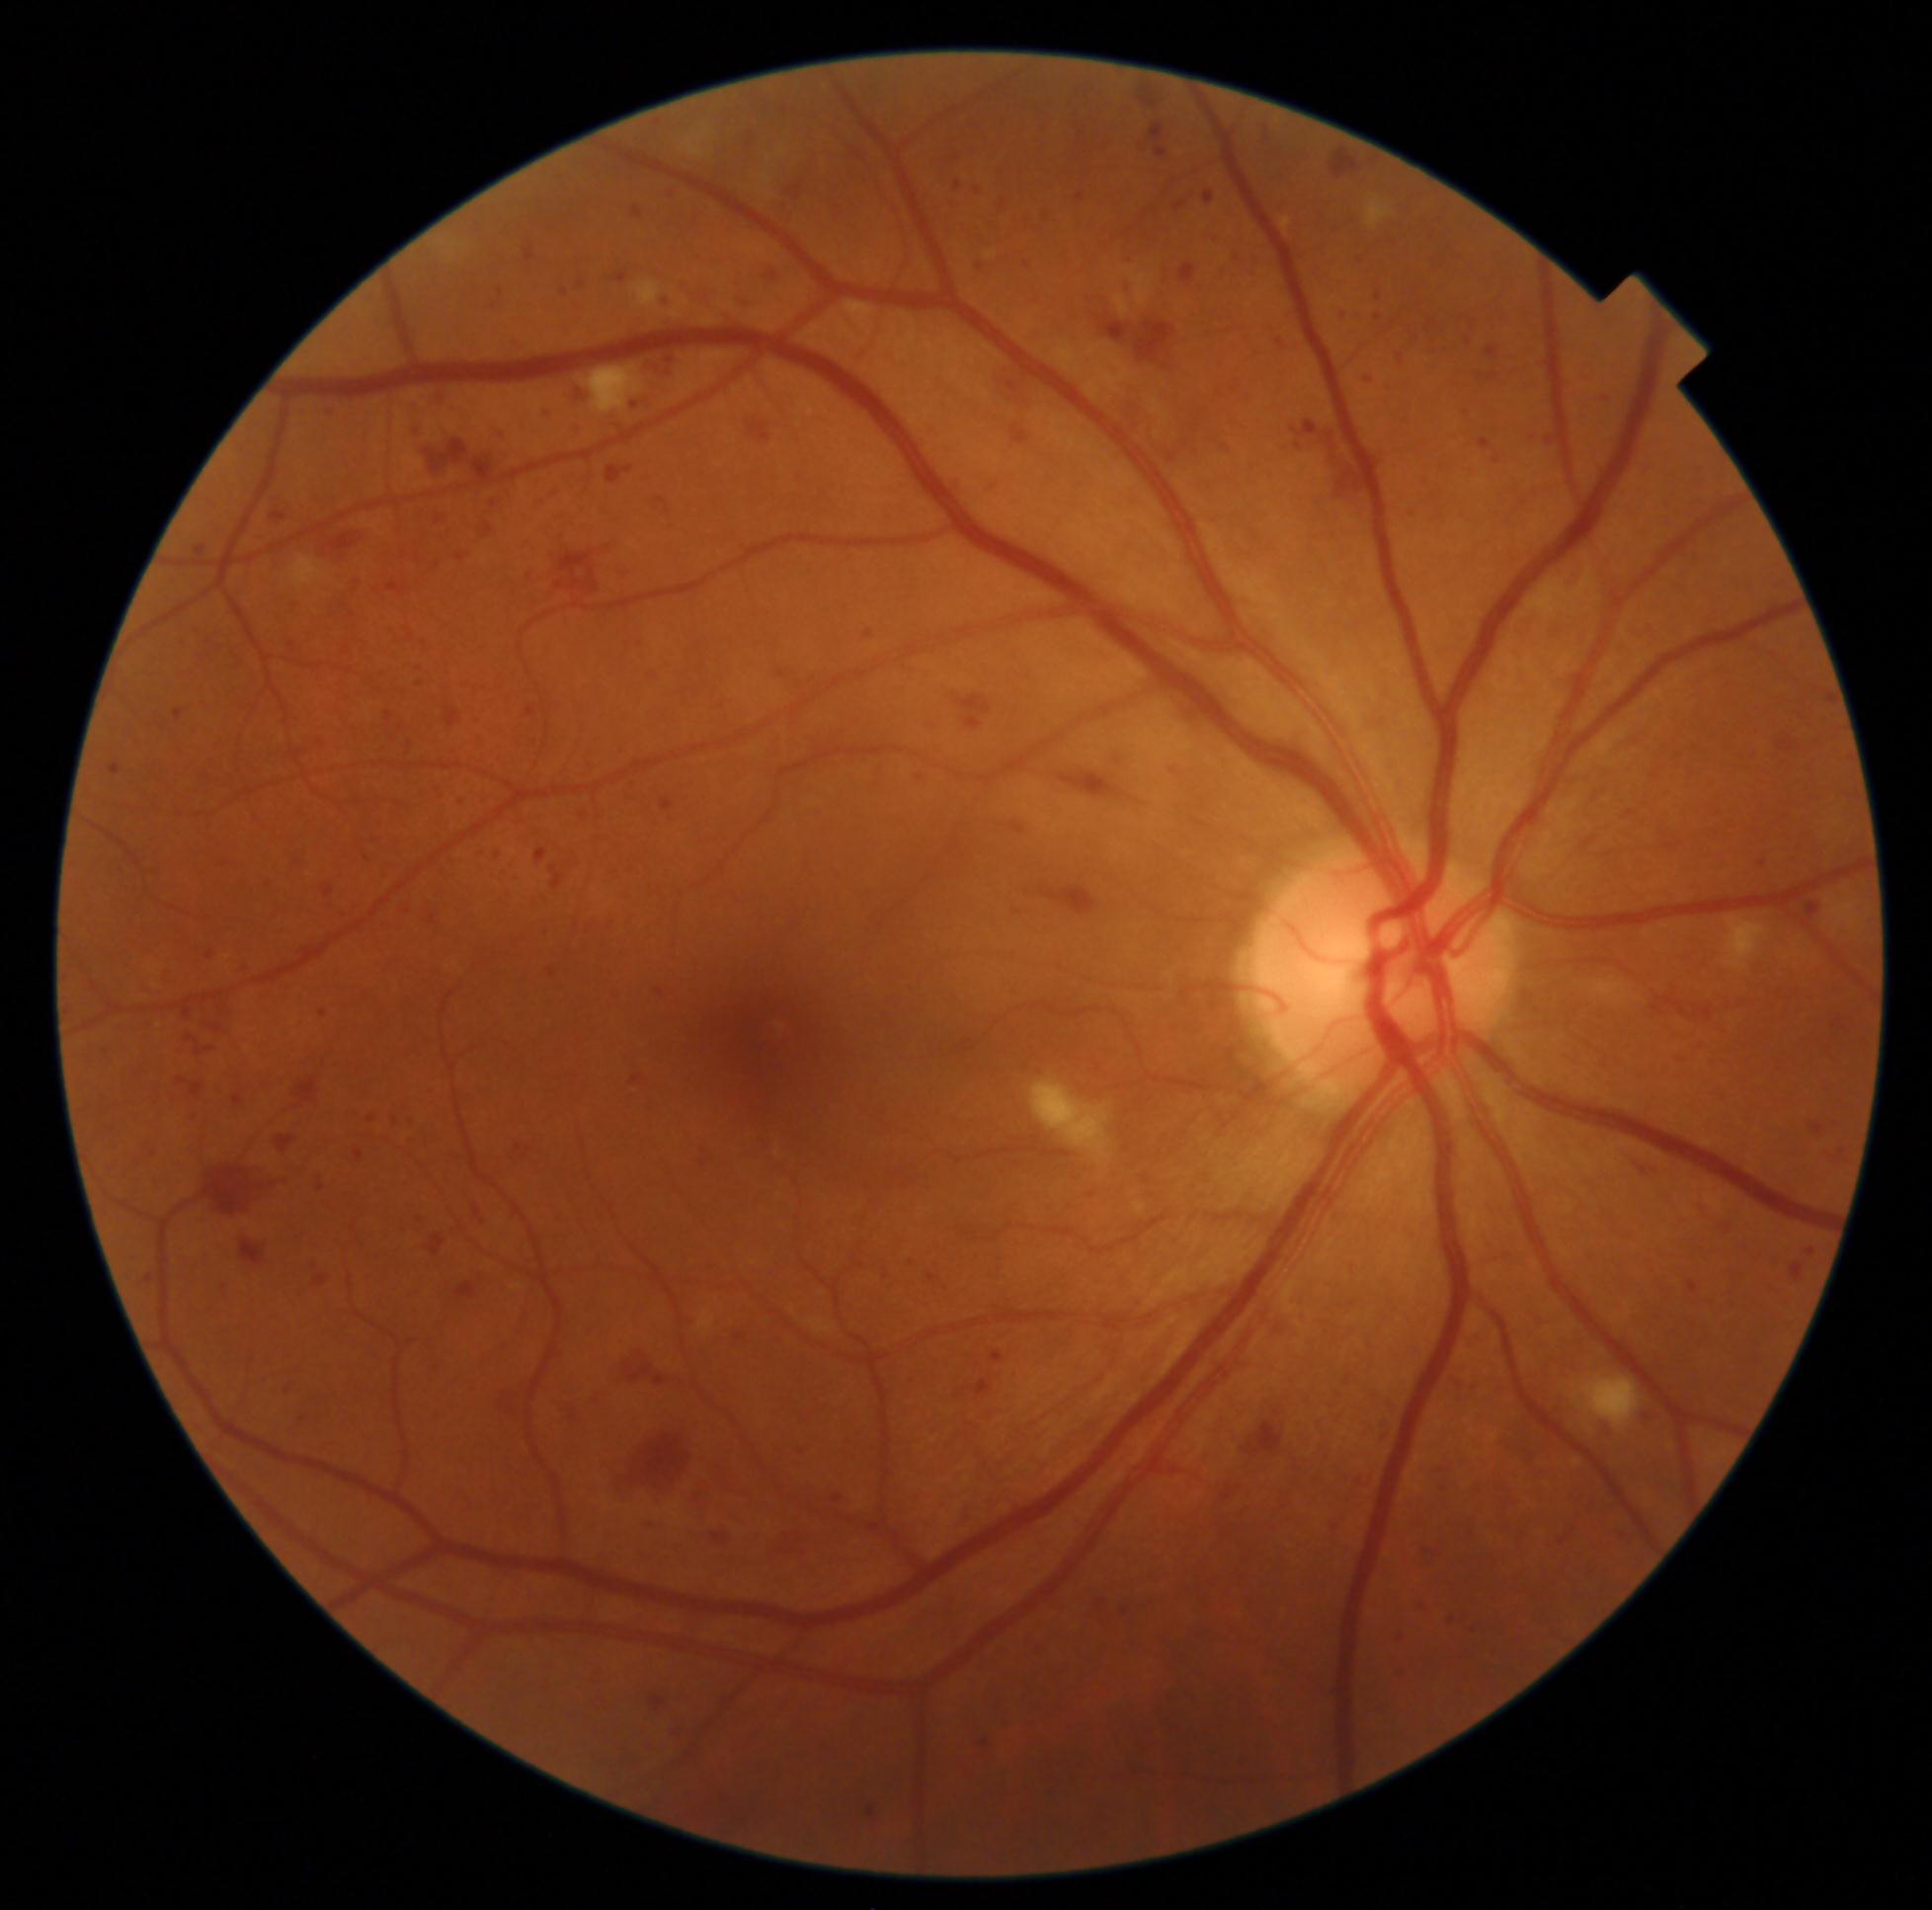
{"partial": true, "dr_grade": 3, "dr_grade_name": "severe NPDR", "lesions": {"he": [[331, 1058, 345, 1071], [312, 527, 378, 562], [210, 856, 239, 870], [65, 996, 79, 1016], [1450, 1372, 1486, 1404], [352, 1147, 369, 1164], [1333, 305, 1348, 321], [1425, 487, 1446, 510], [693, 1140, 716, 1170], [868, 1807, 875, 1818], [354, 434, 364, 444], [1800, 899, 1825, 920], [195, 545, 207, 556], [498, 288, 504, 296], [125, 1252, 141, 1265], [546, 481, 561, 501], [1757, 856, 1771, 868], [1010, 210, 1030, 228]], "he_small_approx": [[1004, 203]]}}